1659x2212px.
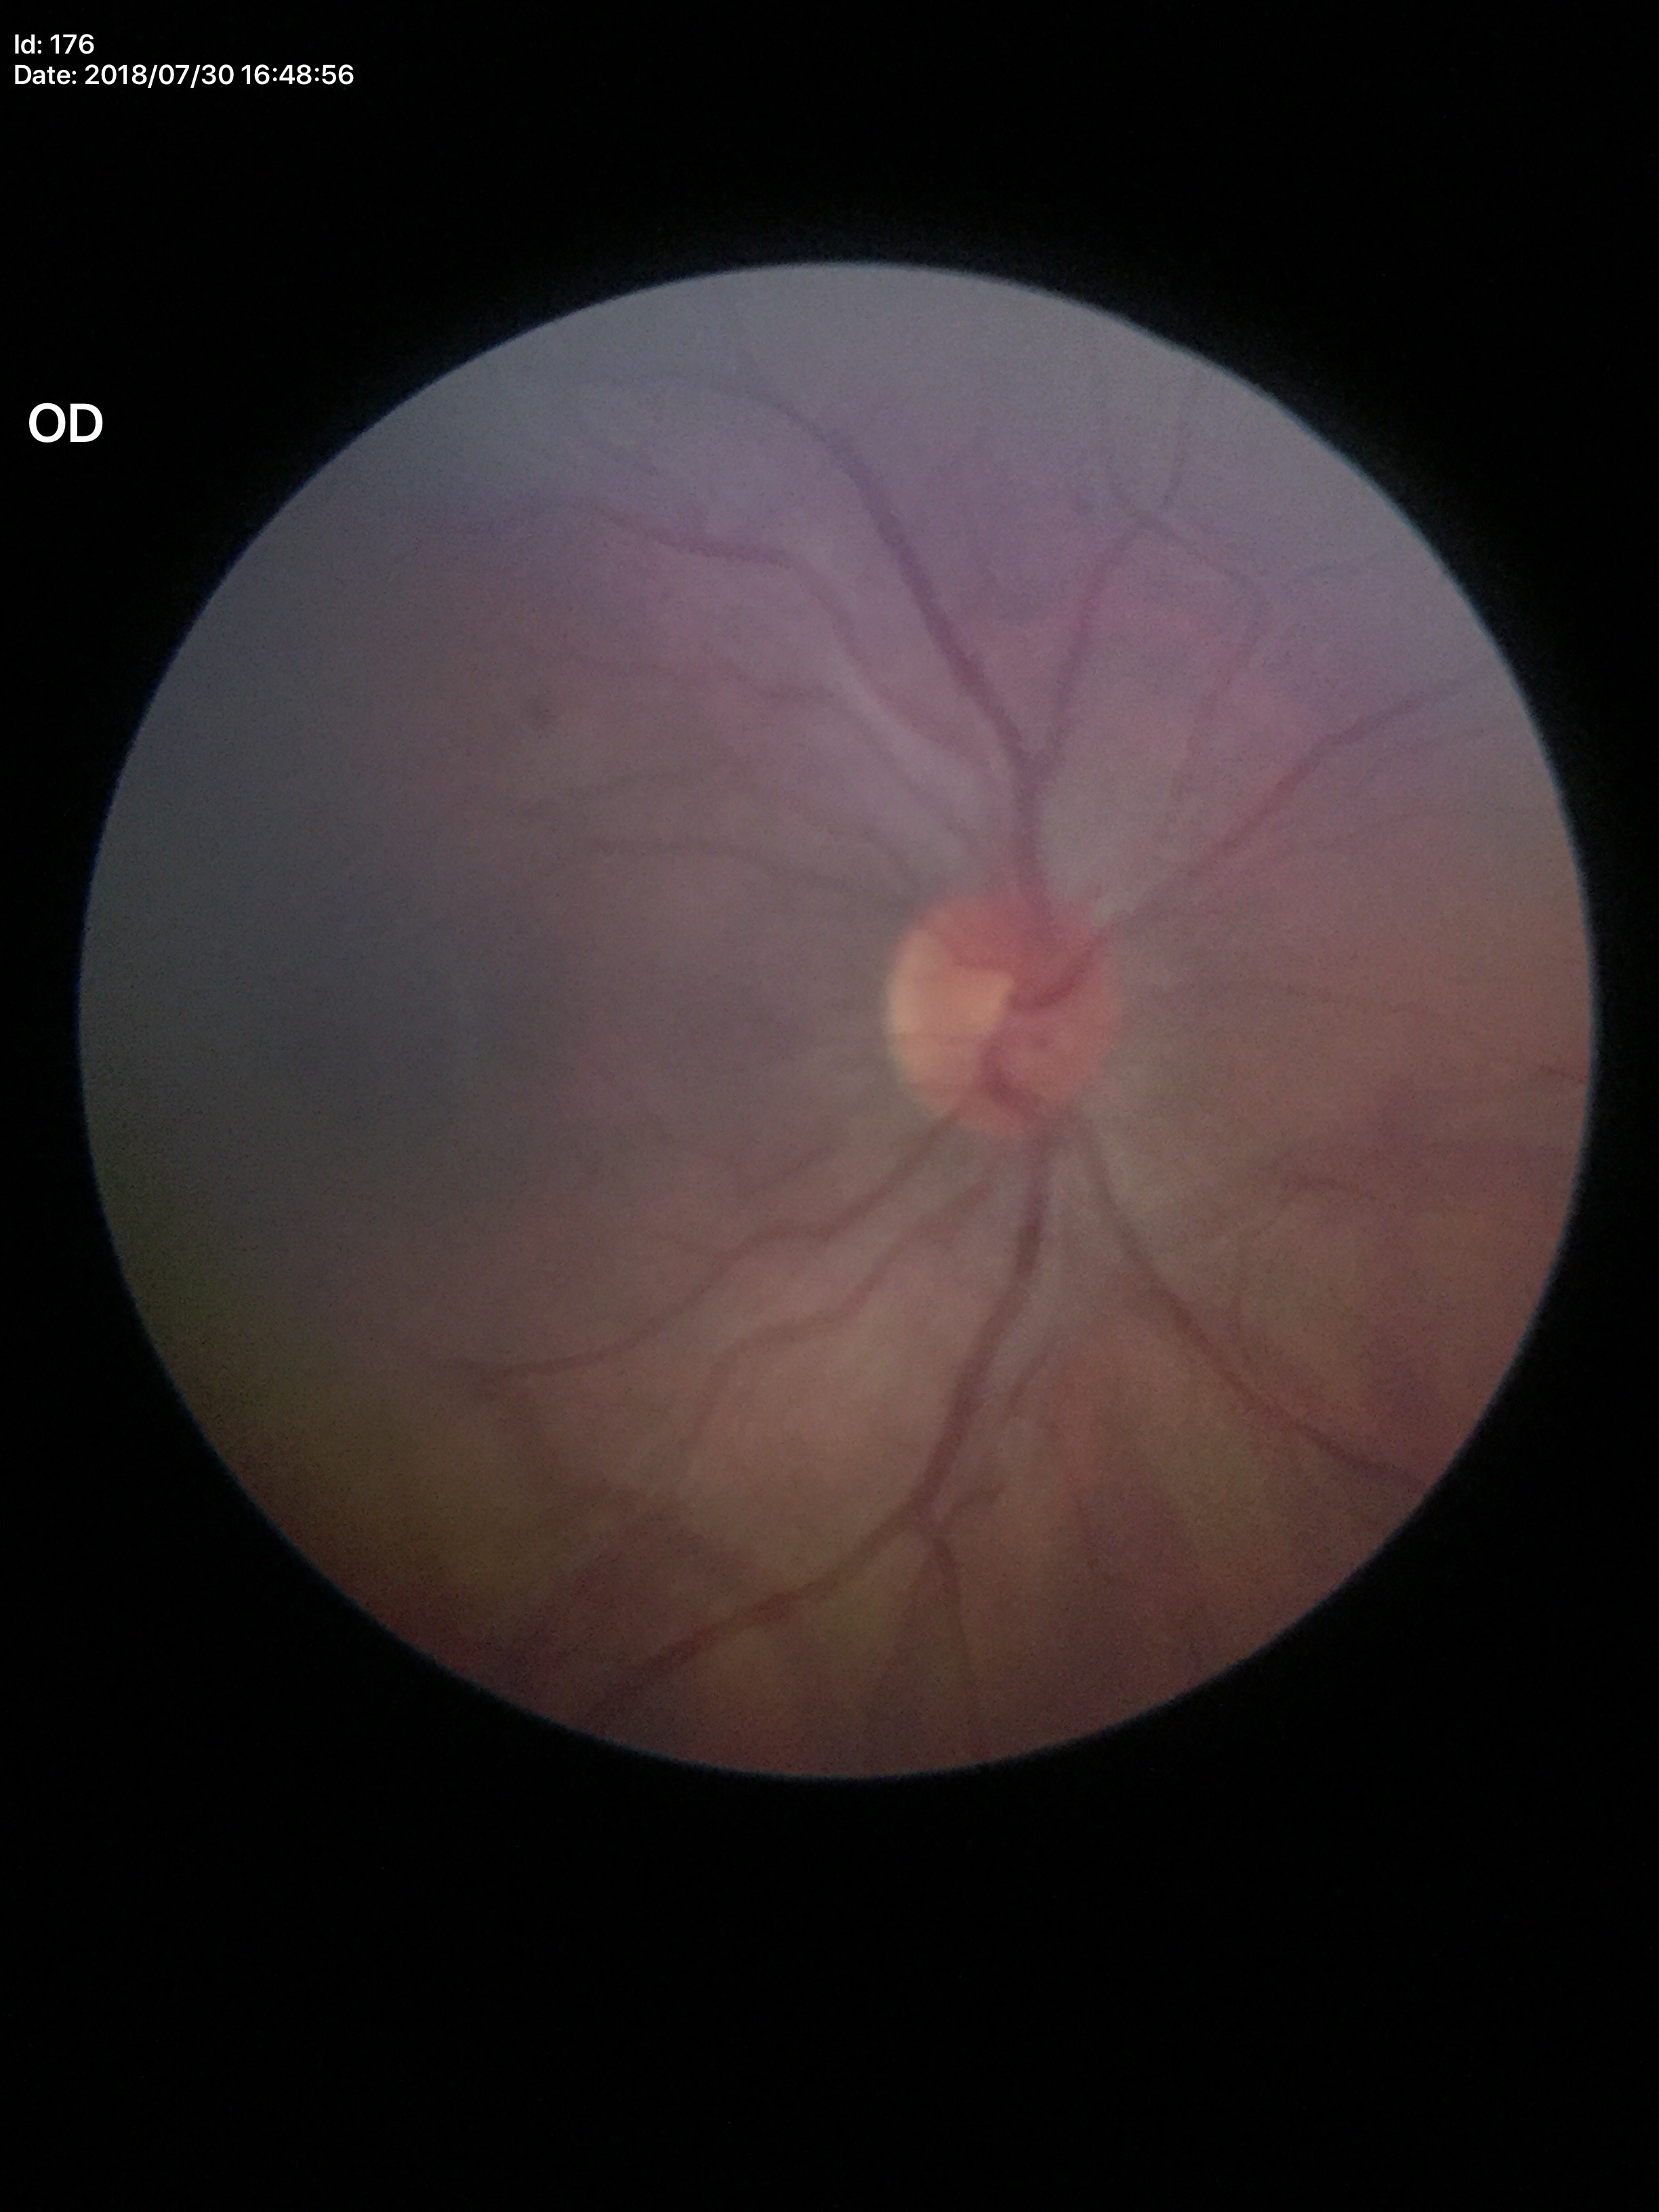
Optic disc analysis:
* Glaucoma assessment: negative (5/5 ophthalmologists in agreement)
* HCDR: 0.47
* VCDR: 0.49